Infant wide-field retinal image · acquired on the Phoenix ICON
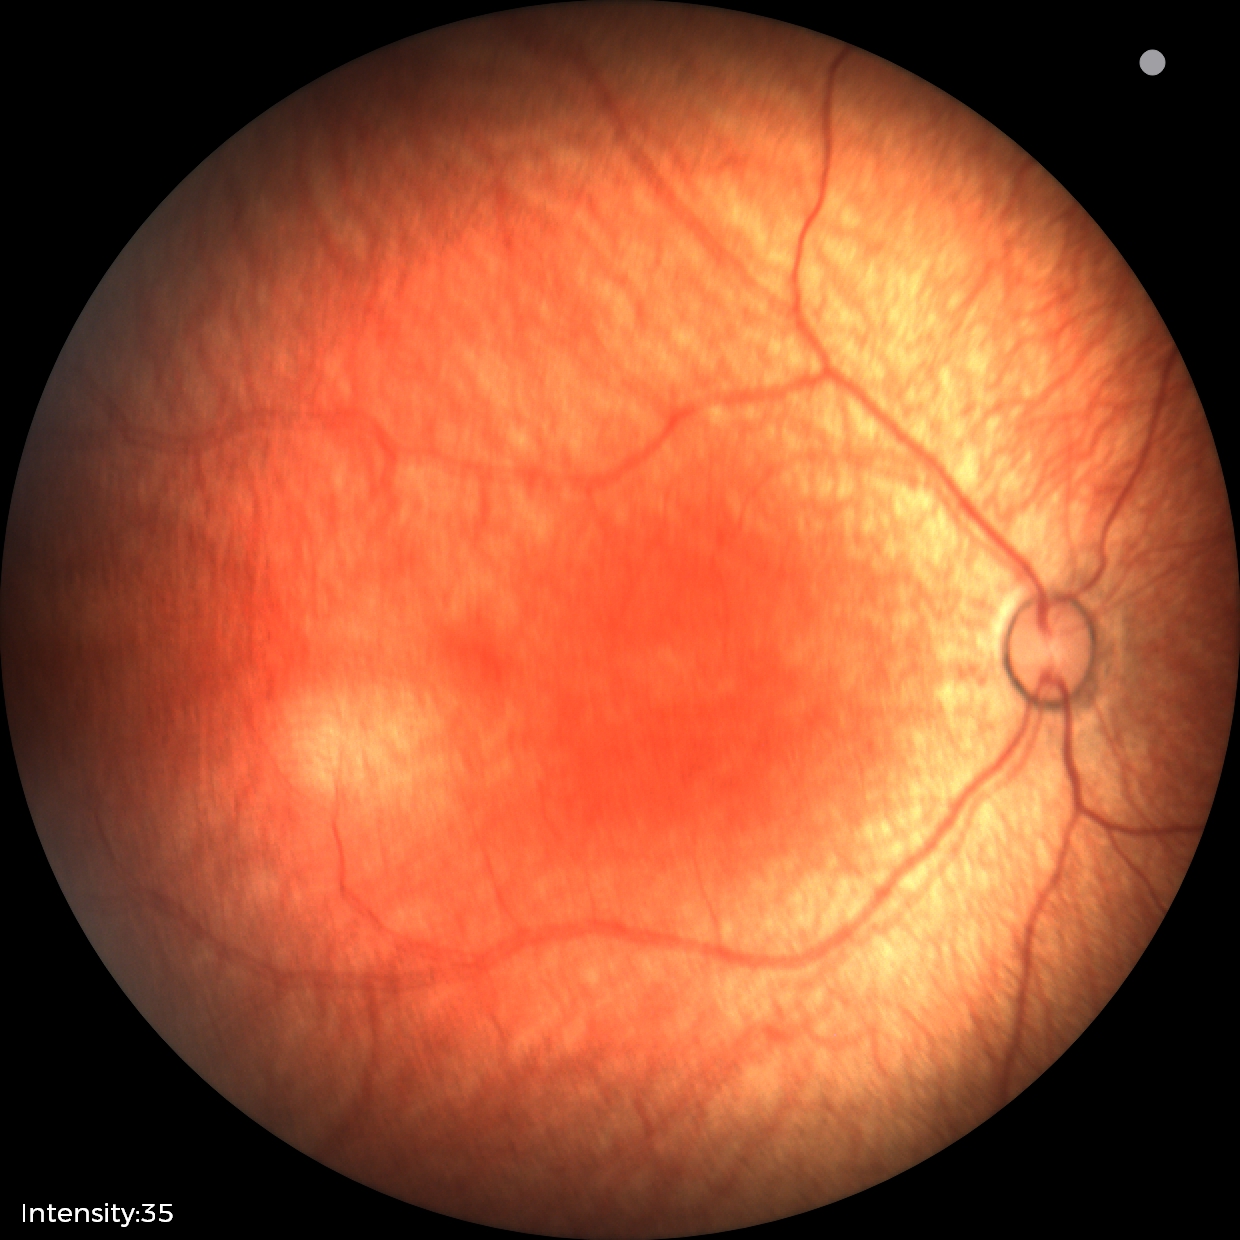 No retinal pathology identified on screening.